FOV: 200 degrees, ultra-widefield fundus mosaic, 1924 x 1556 pixels.
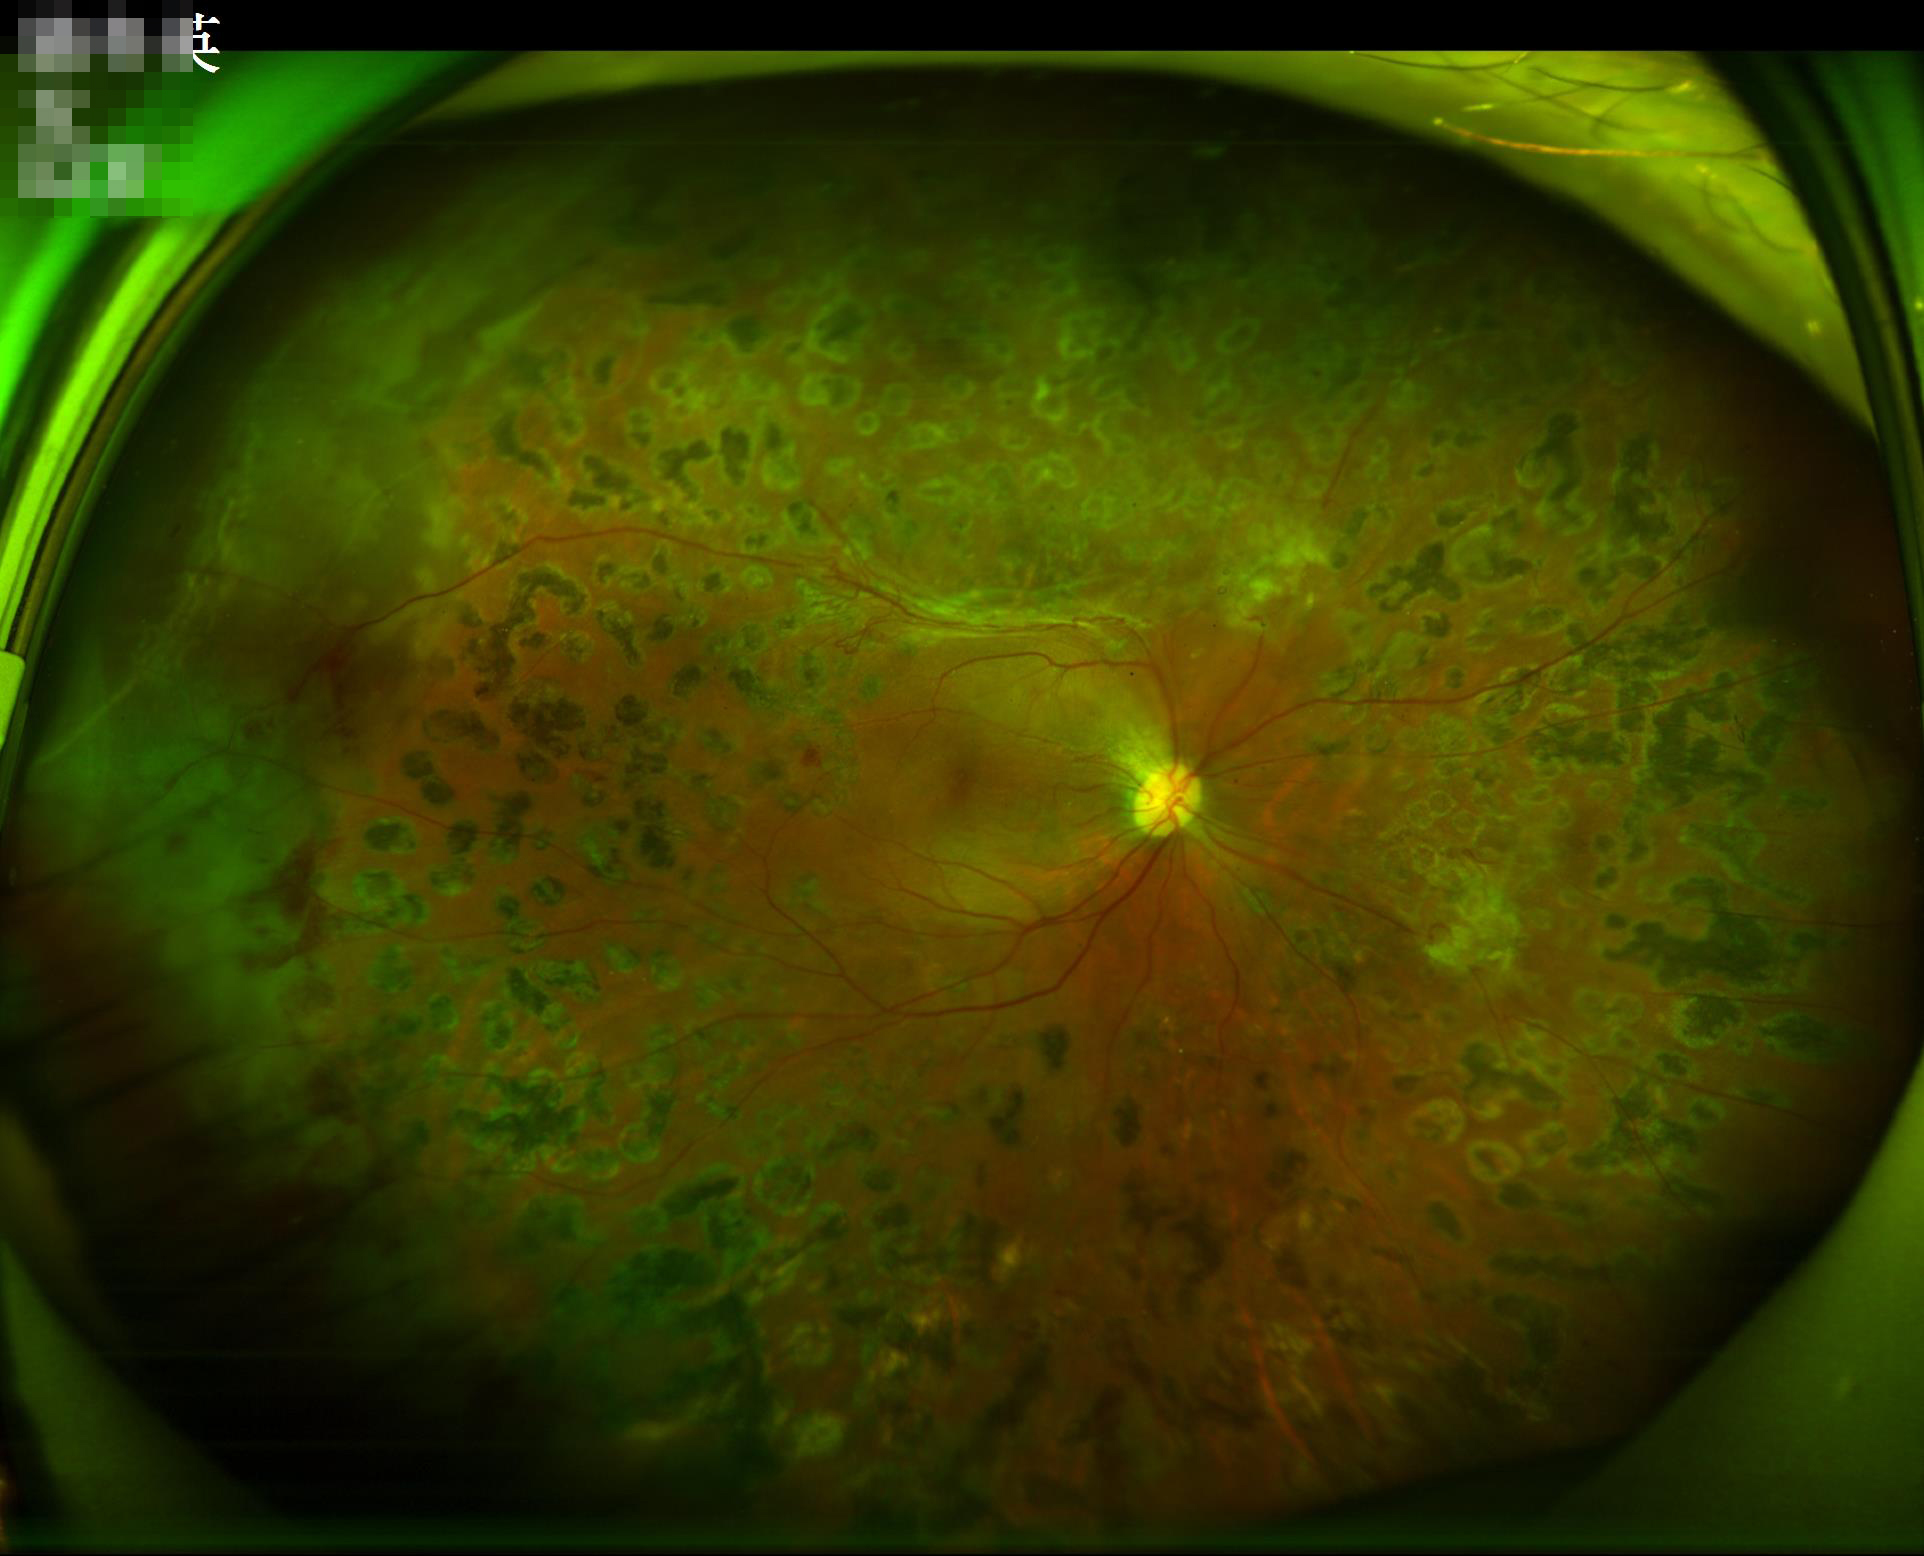
Focus: optic disc, vessels, and background in focus | Contrast: wide intensity range, structures distinguishable | Overall image quality: adequate for clinical interpretation | Illumination: even and well-balanced.